No pharmacologic dilation. DR severity per modified Davis staging. NIDEK AFC-230. Color fundus image.
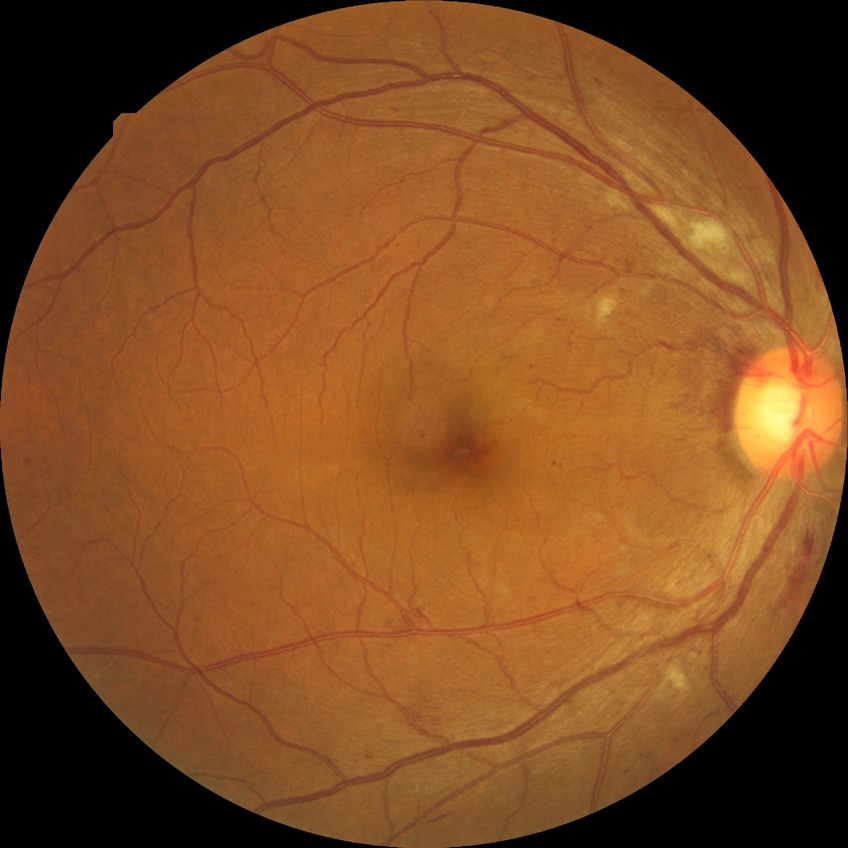
Diabetic retinopathy (DR) is pre-proliferative diabetic retinopathy (PPDR).